Color fundus photograph: 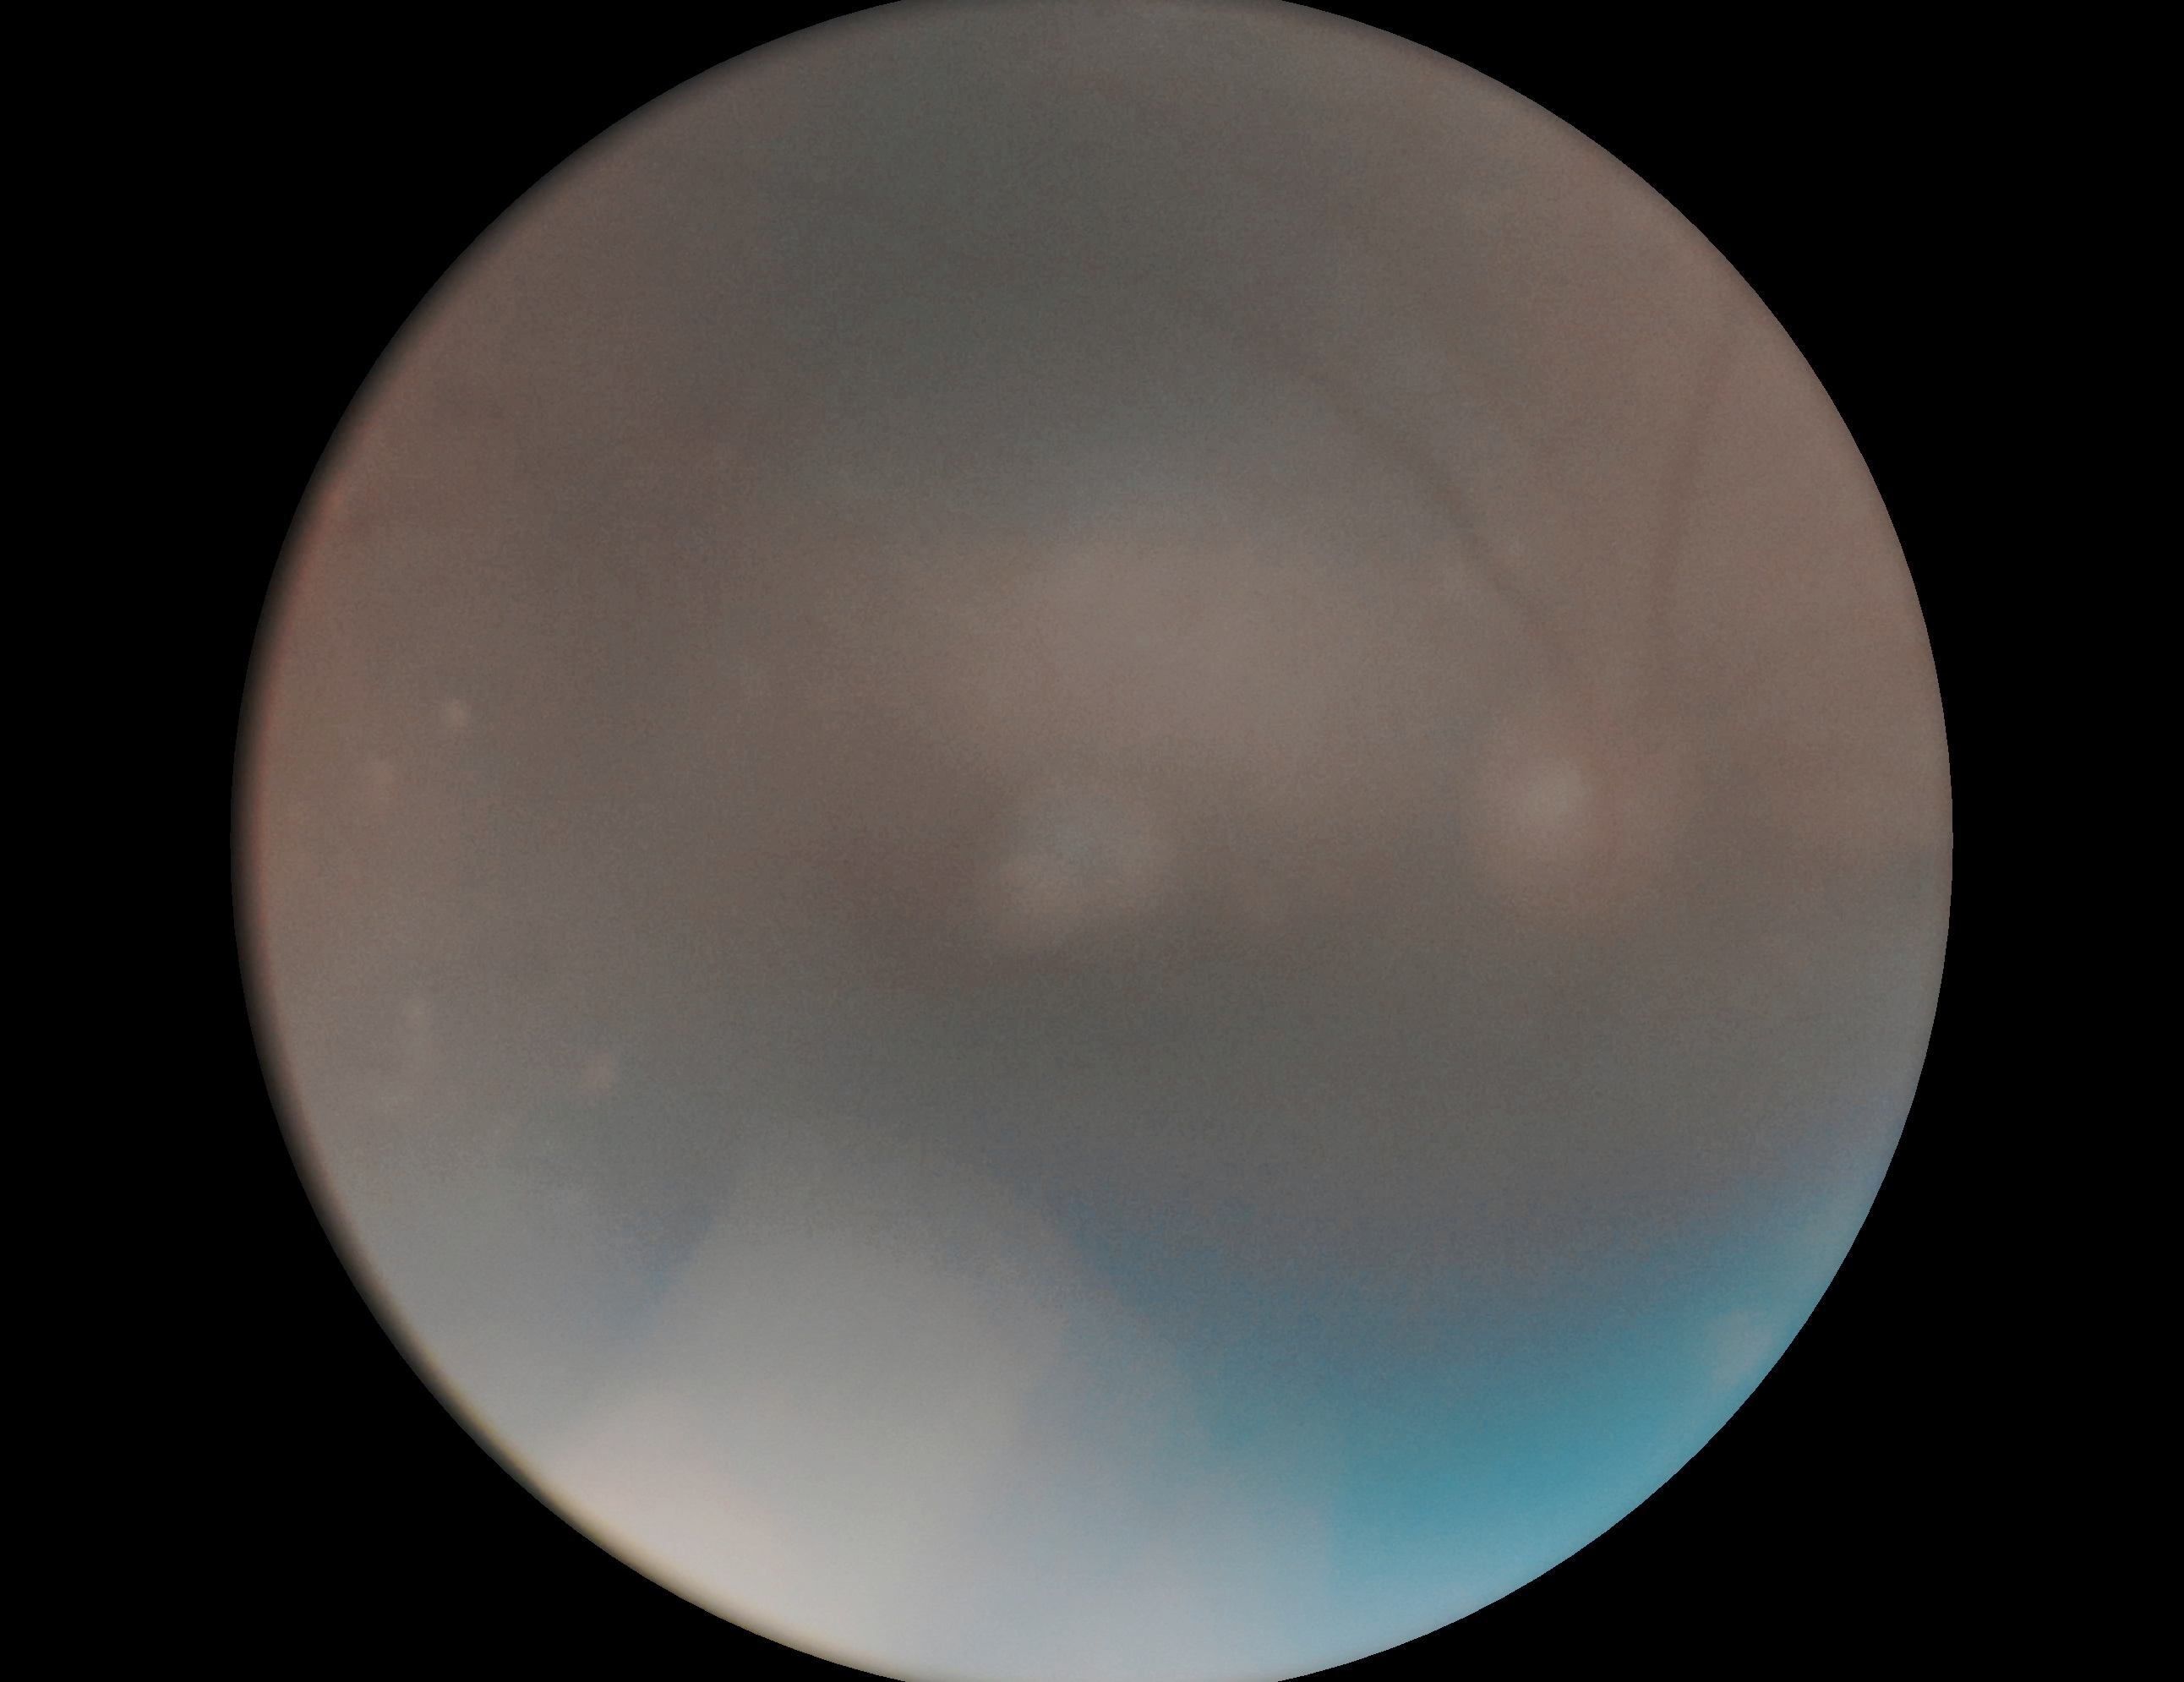
DR severity is ungradable due to poor image quality.
Ungradable image — DR severity cannot be determined.